Camera: Topcon TRC-50DX.
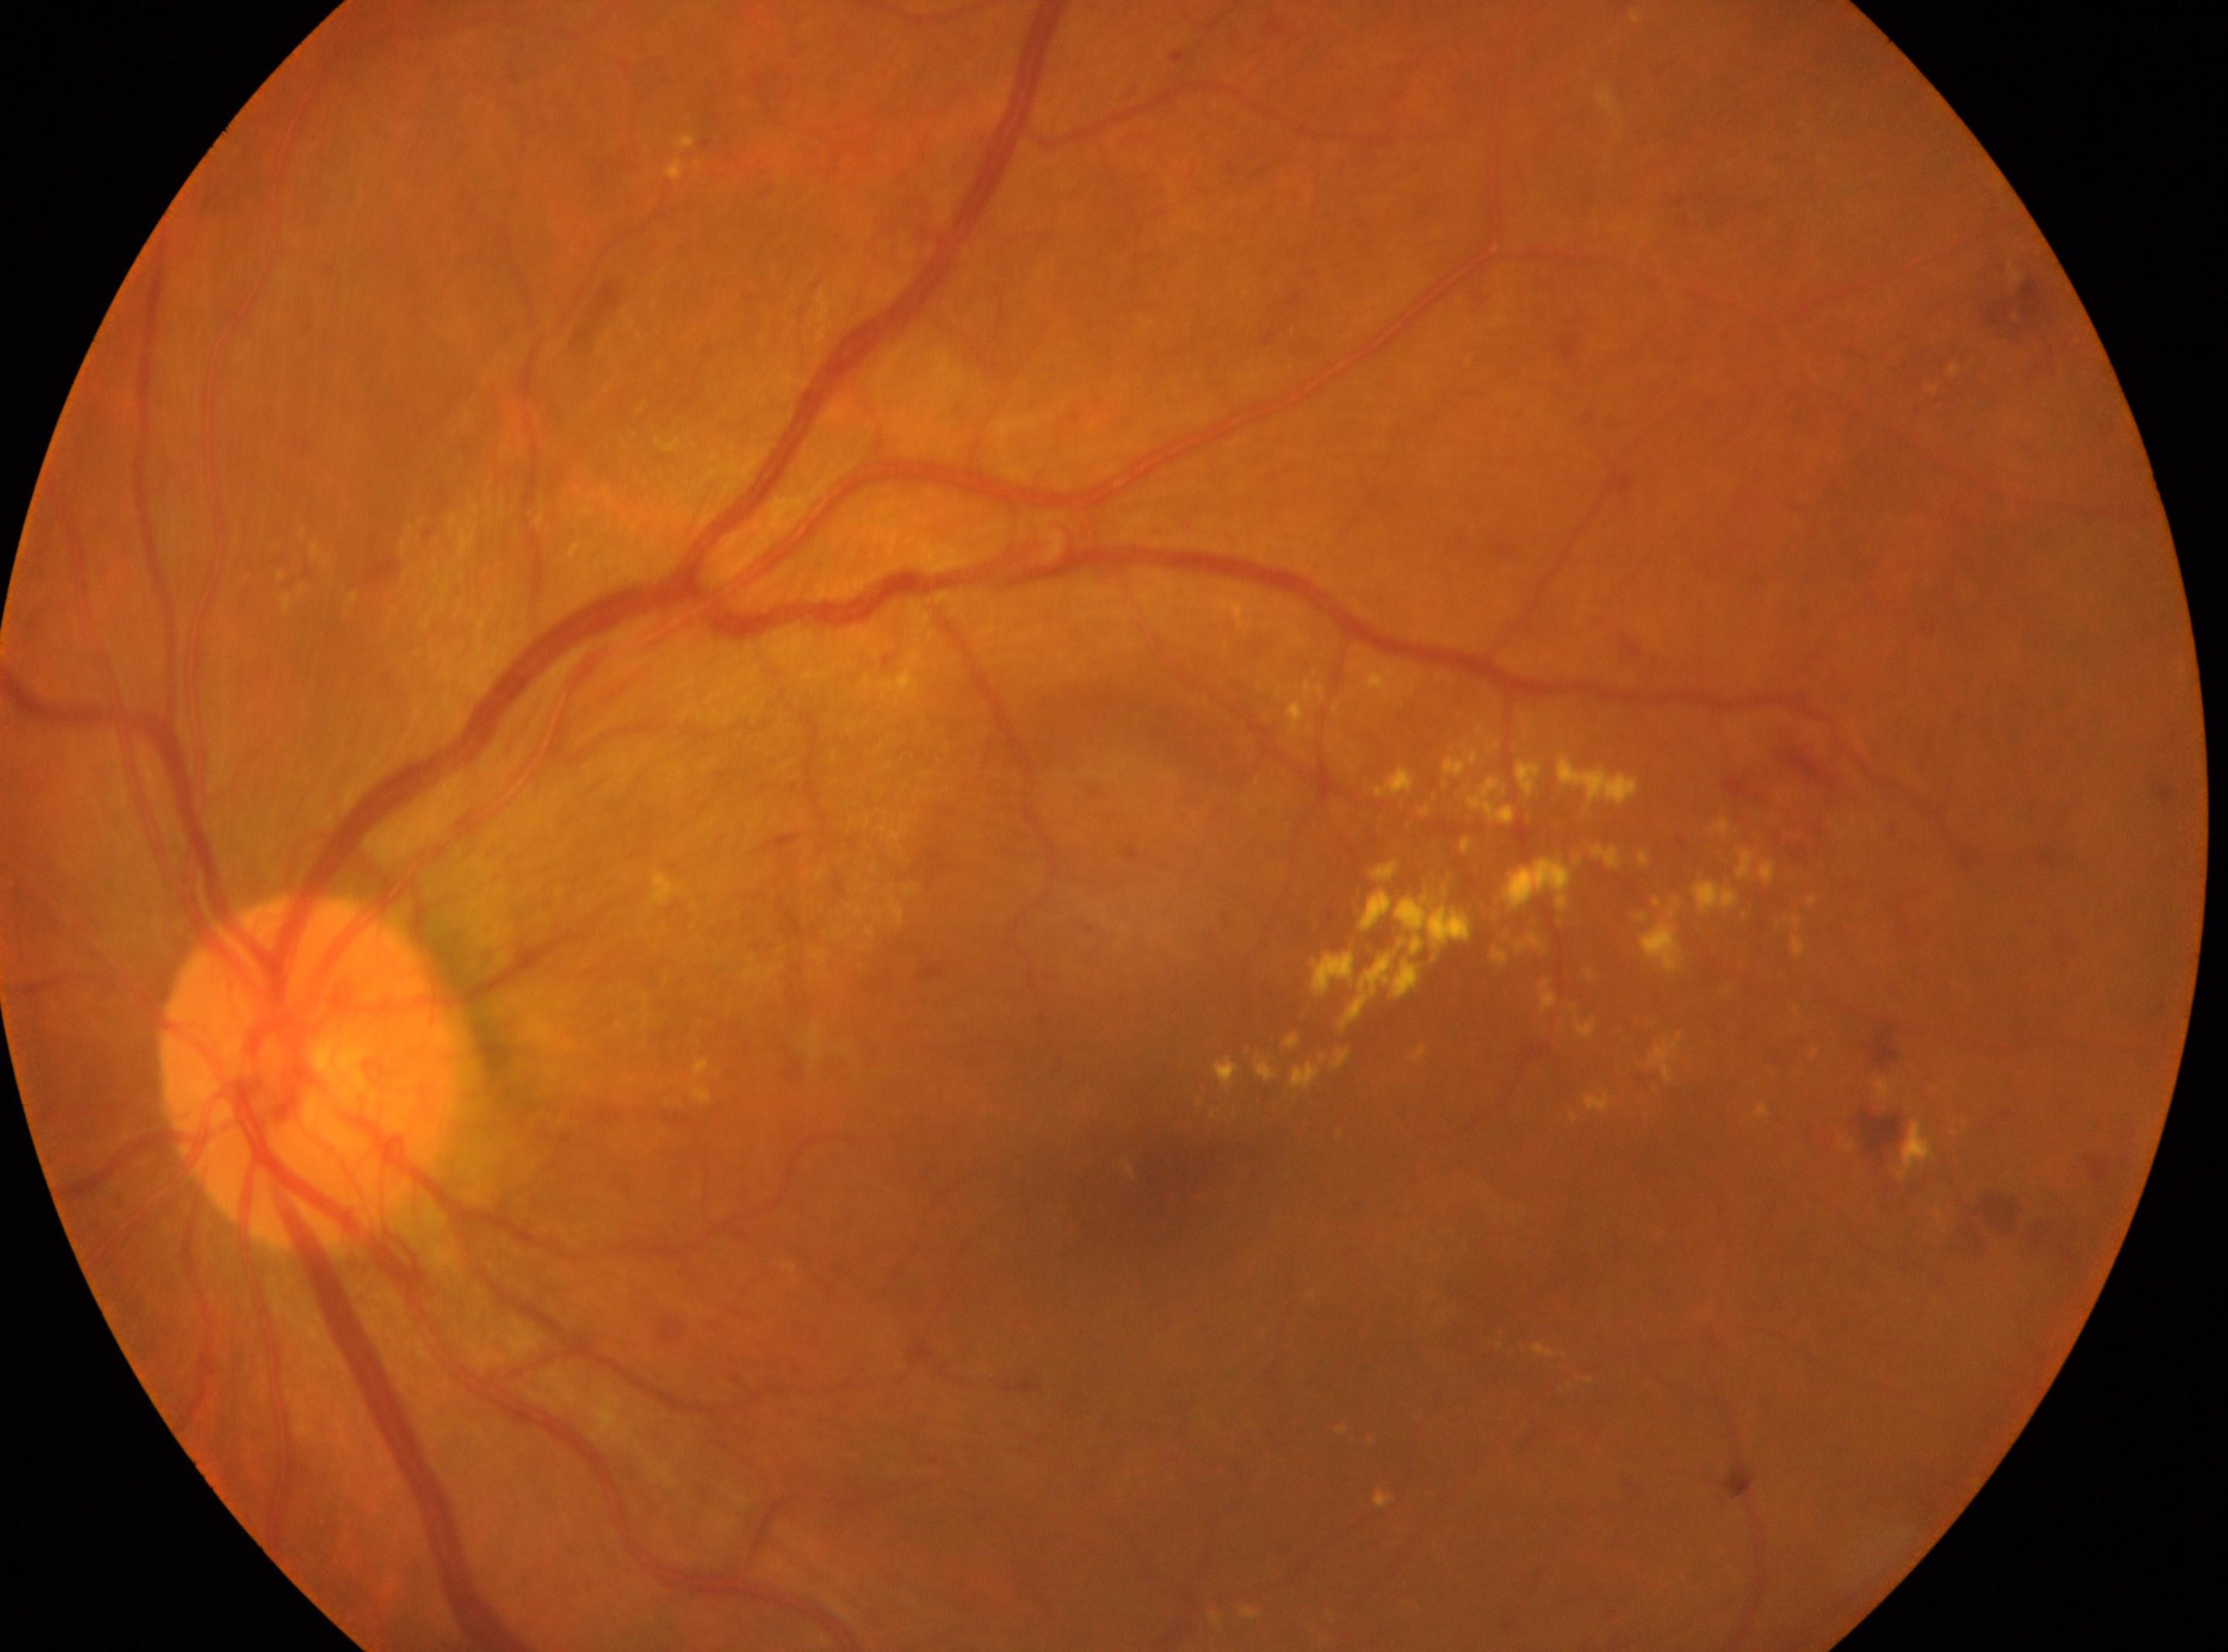 The optic nerve head is at x=309, y=1072. Eye: left. DR stage is moderate non-proliferative diabetic retinopathy (grade 2). Fovea located at x=1139, y=1191.